Nonmydriatic fundus photograph.
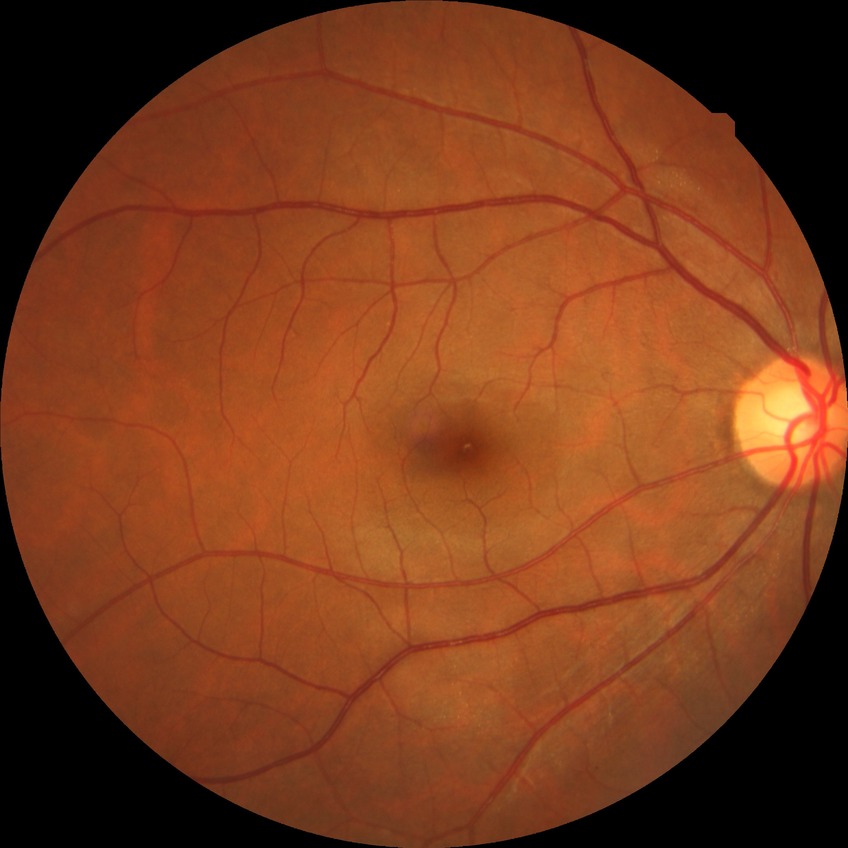

davis_grade: no diabetic retinopathy